640 by 480 pixels · infant wide-field fundus photograph:
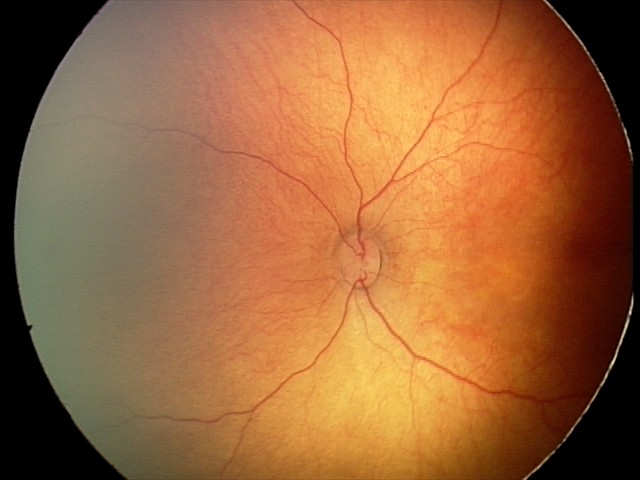

Normal screening examination.